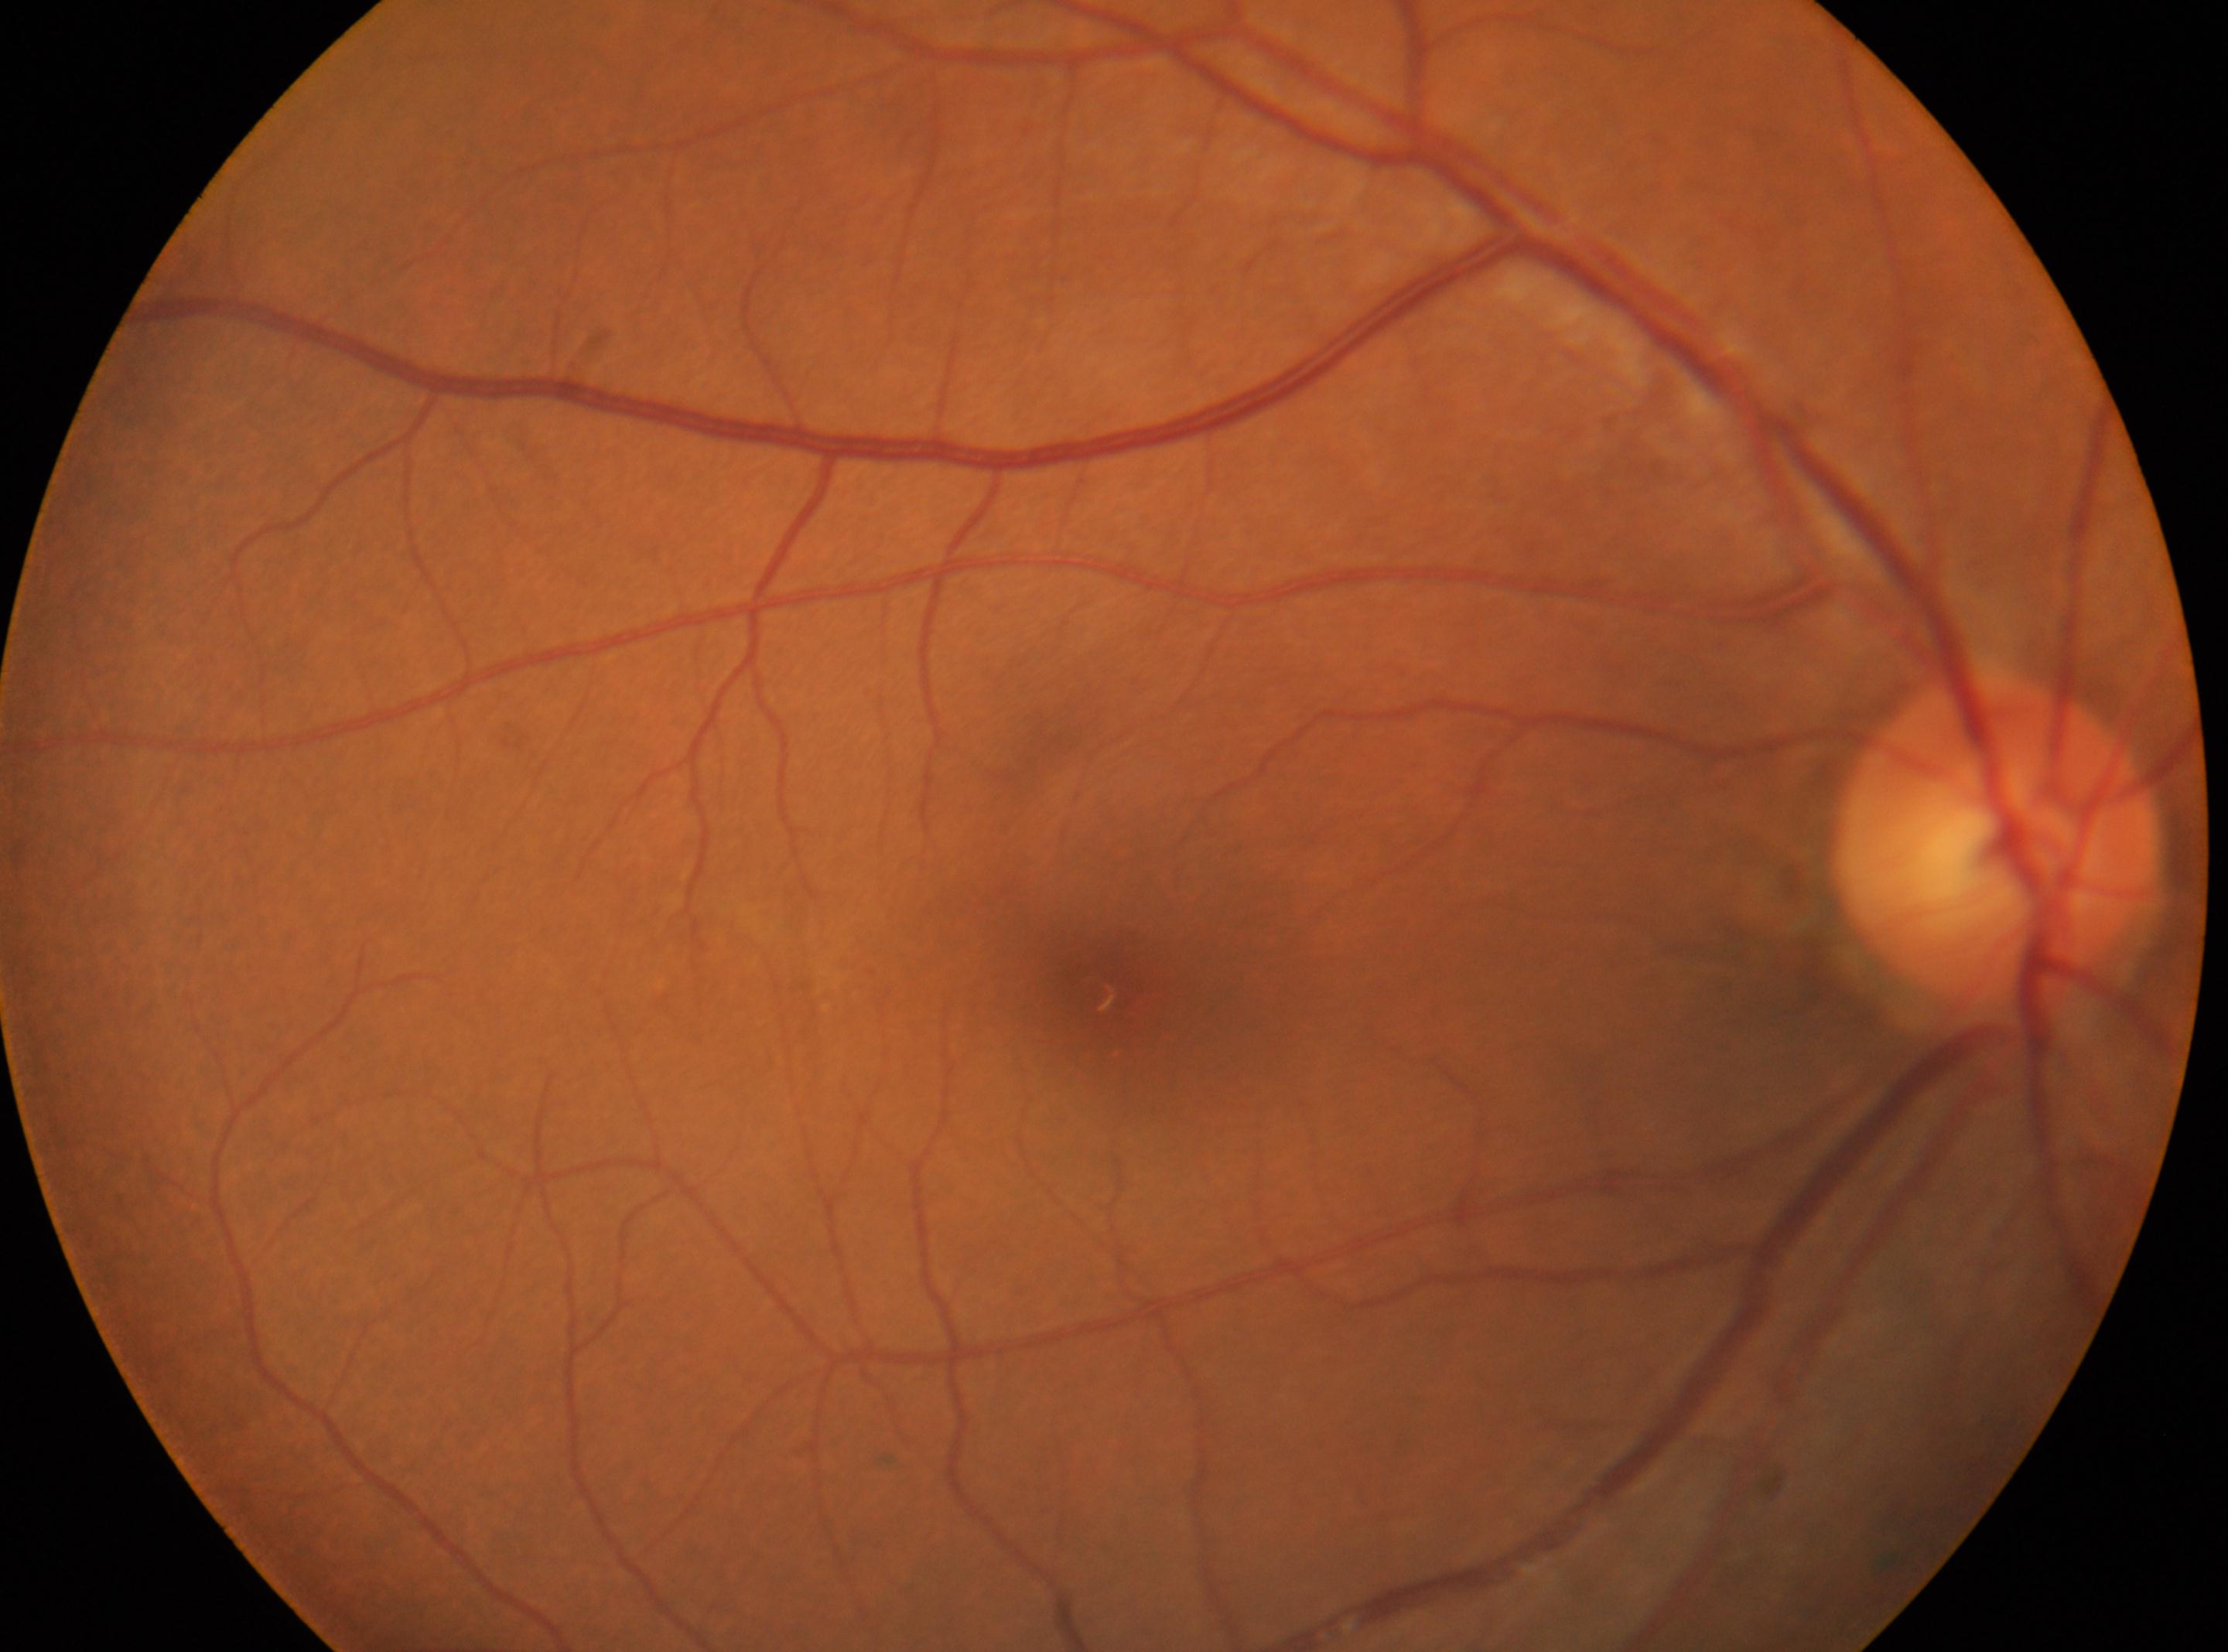

ONH located at x=1996, y=835.
Imaged eye: the right eye.
The macular center is at x=1117, y=984.
DR stage: 0.